Wide-field fundus photograph of an infant.
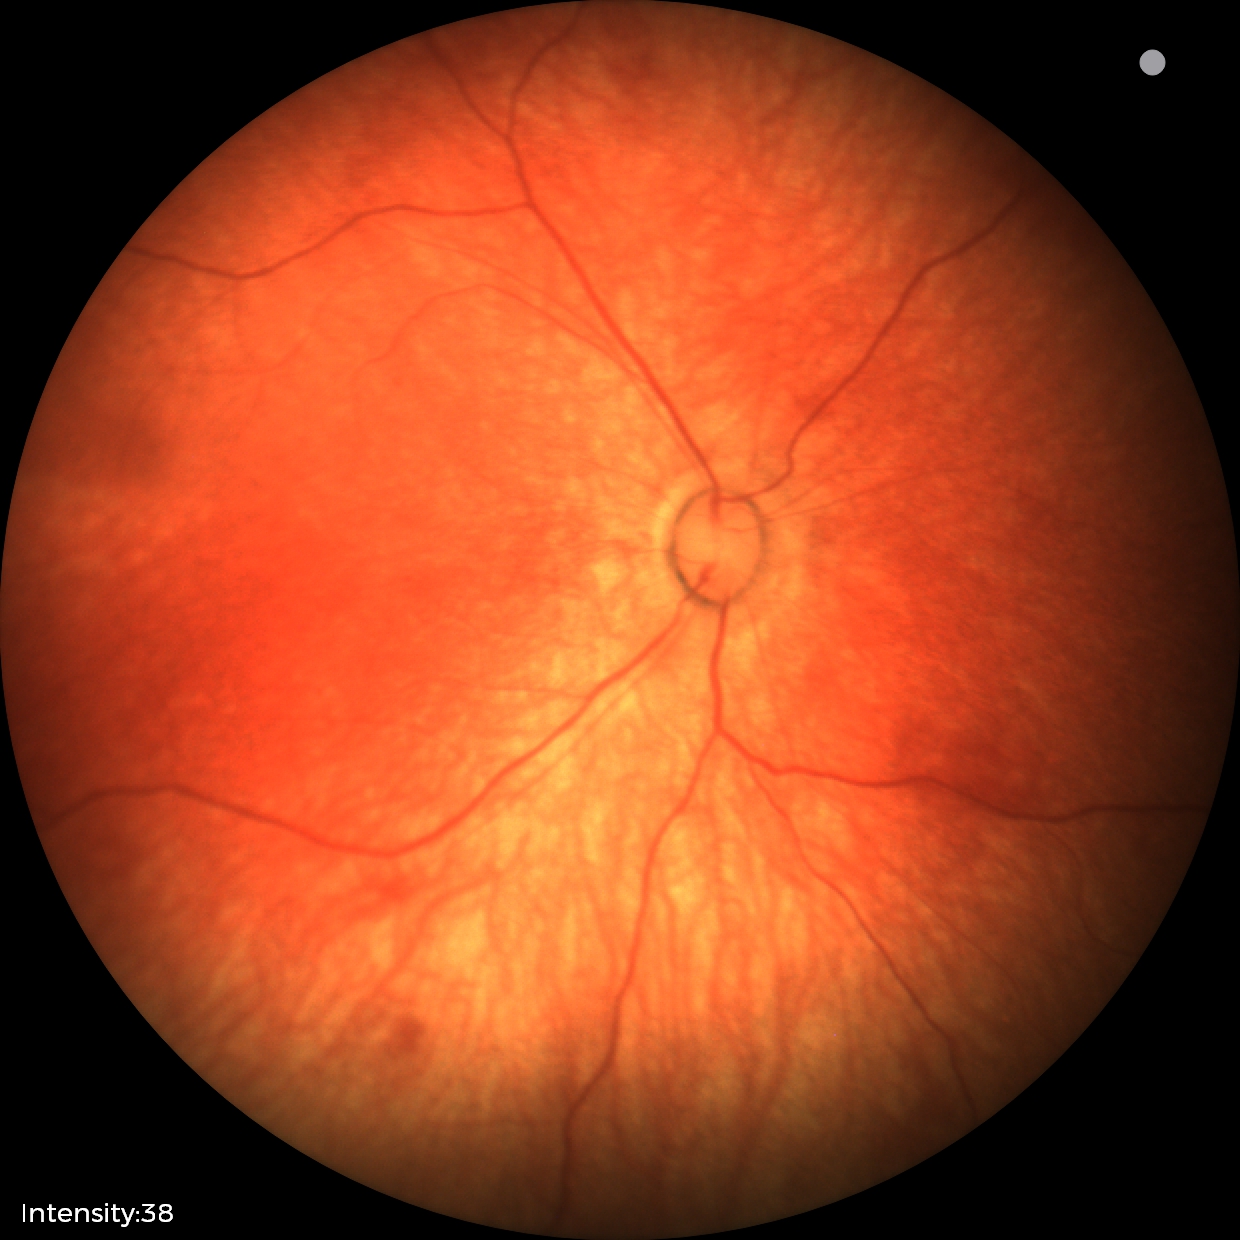

No retinal pathology identified on screening.